Image size 240x240; fundus photo; optic nerve head crop: 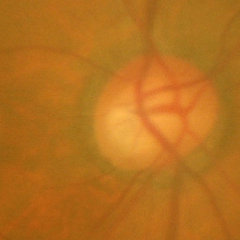

Glaucomatous changes are present.
Advanced glaucomatous optic neuropathy.
Diagnostic criteria: near-total cupping of the optic nerve head, with or without severe visual field loss within the central 10 degrees of fixation.